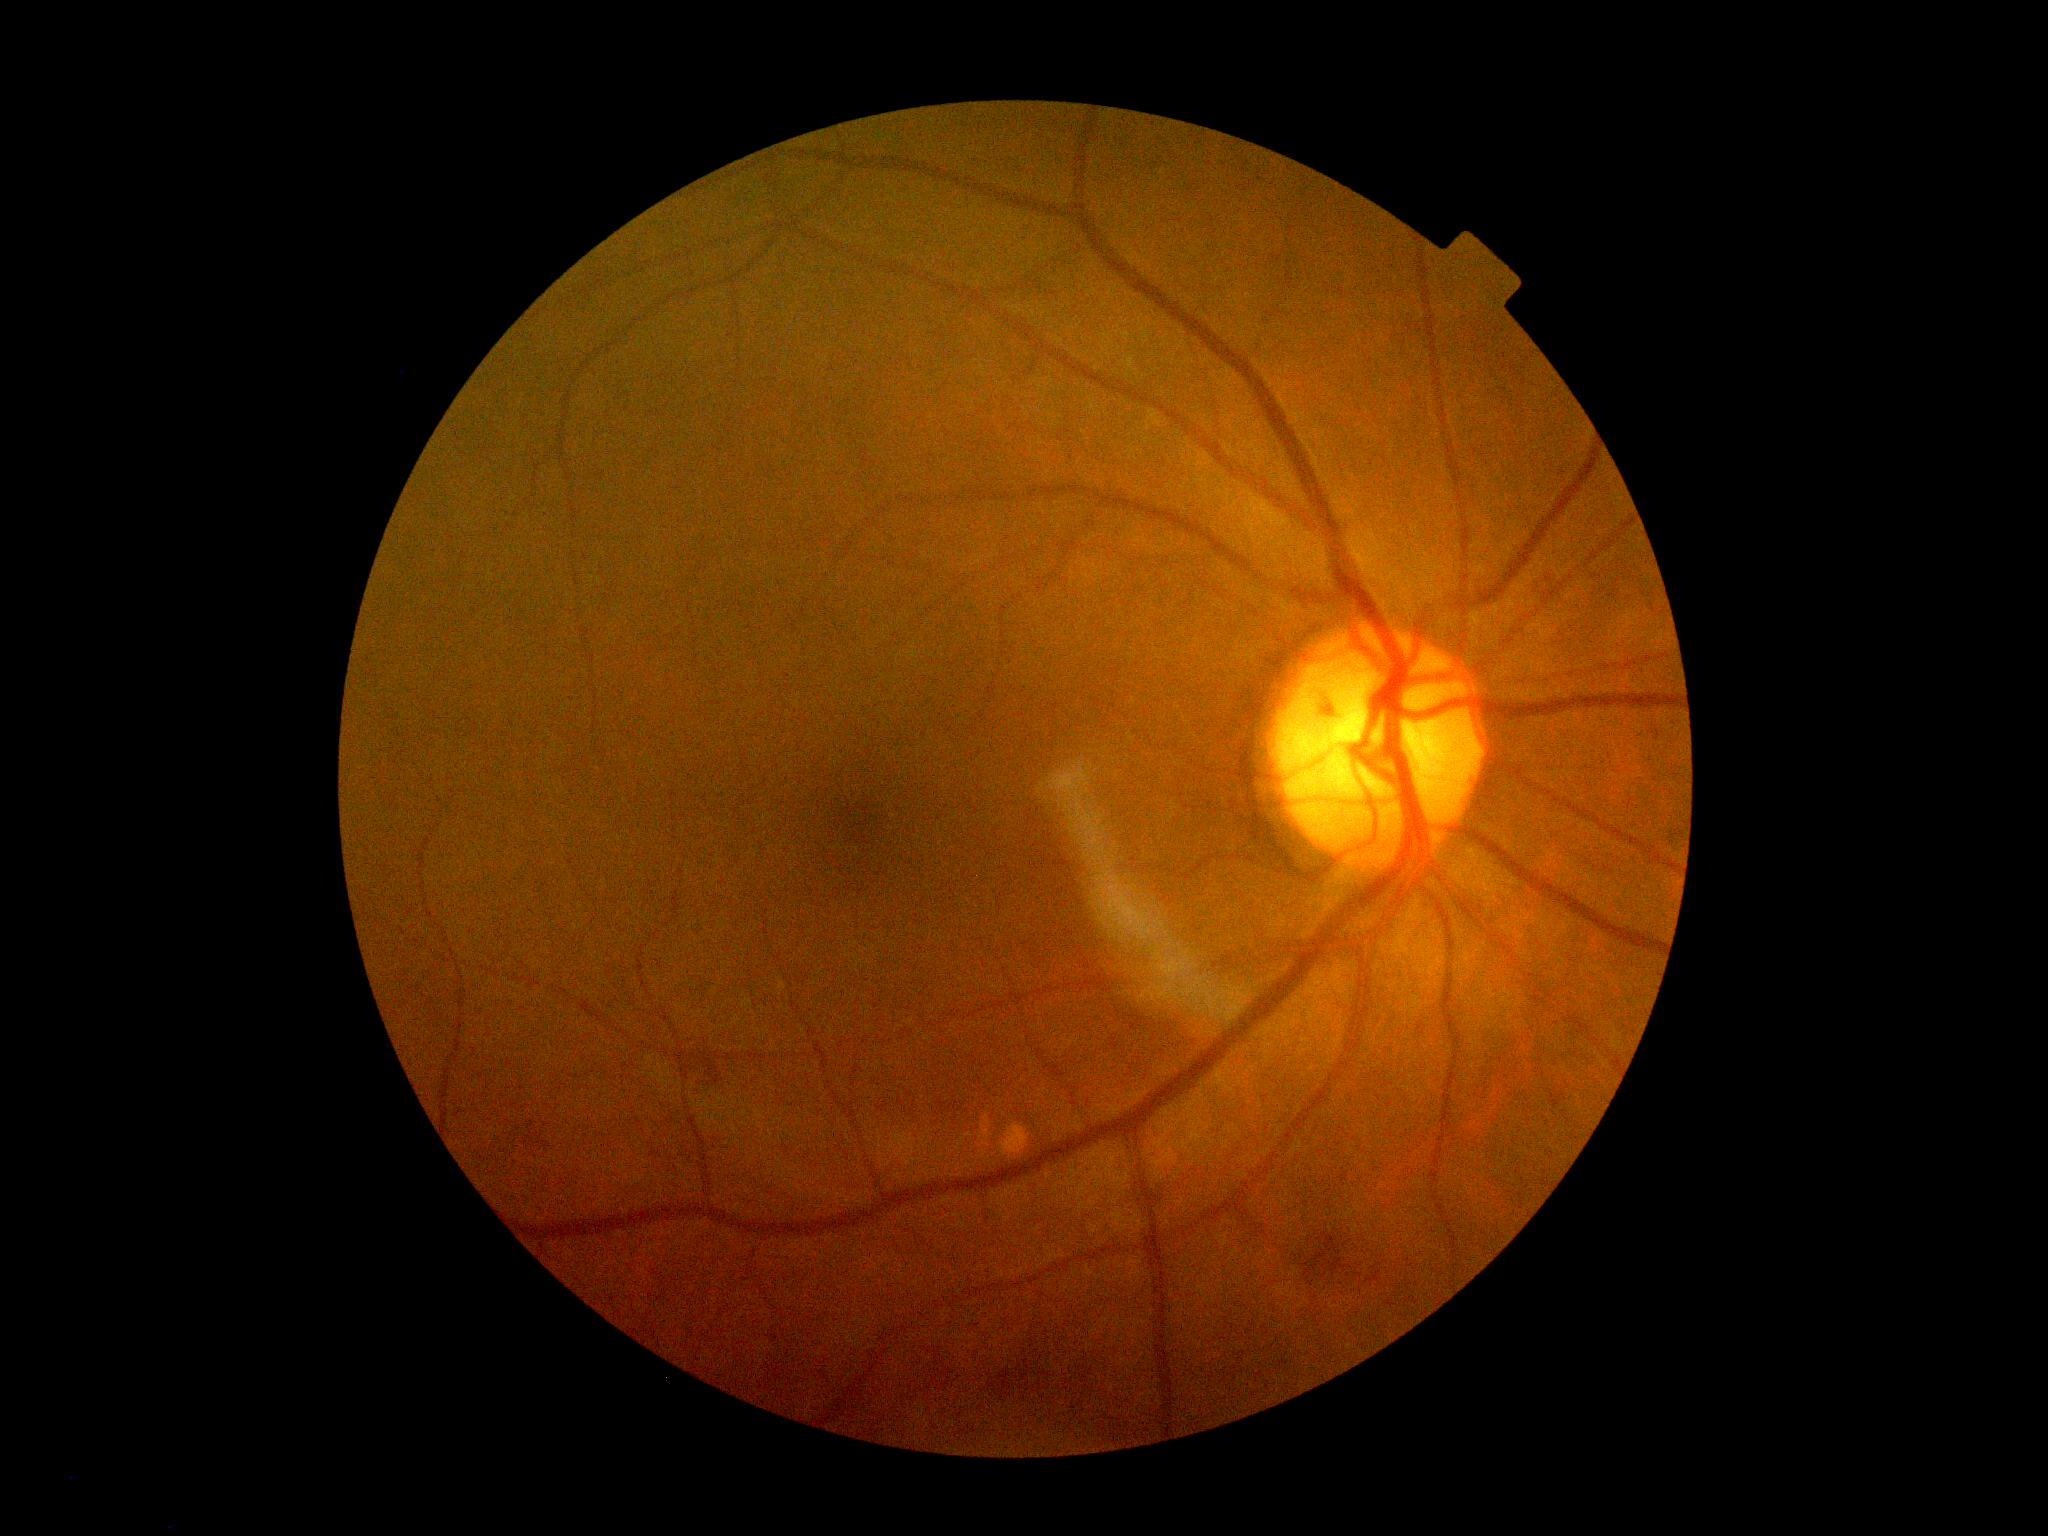 * diabetic retinopathy (DR): grade 2 (moderate NPDR)